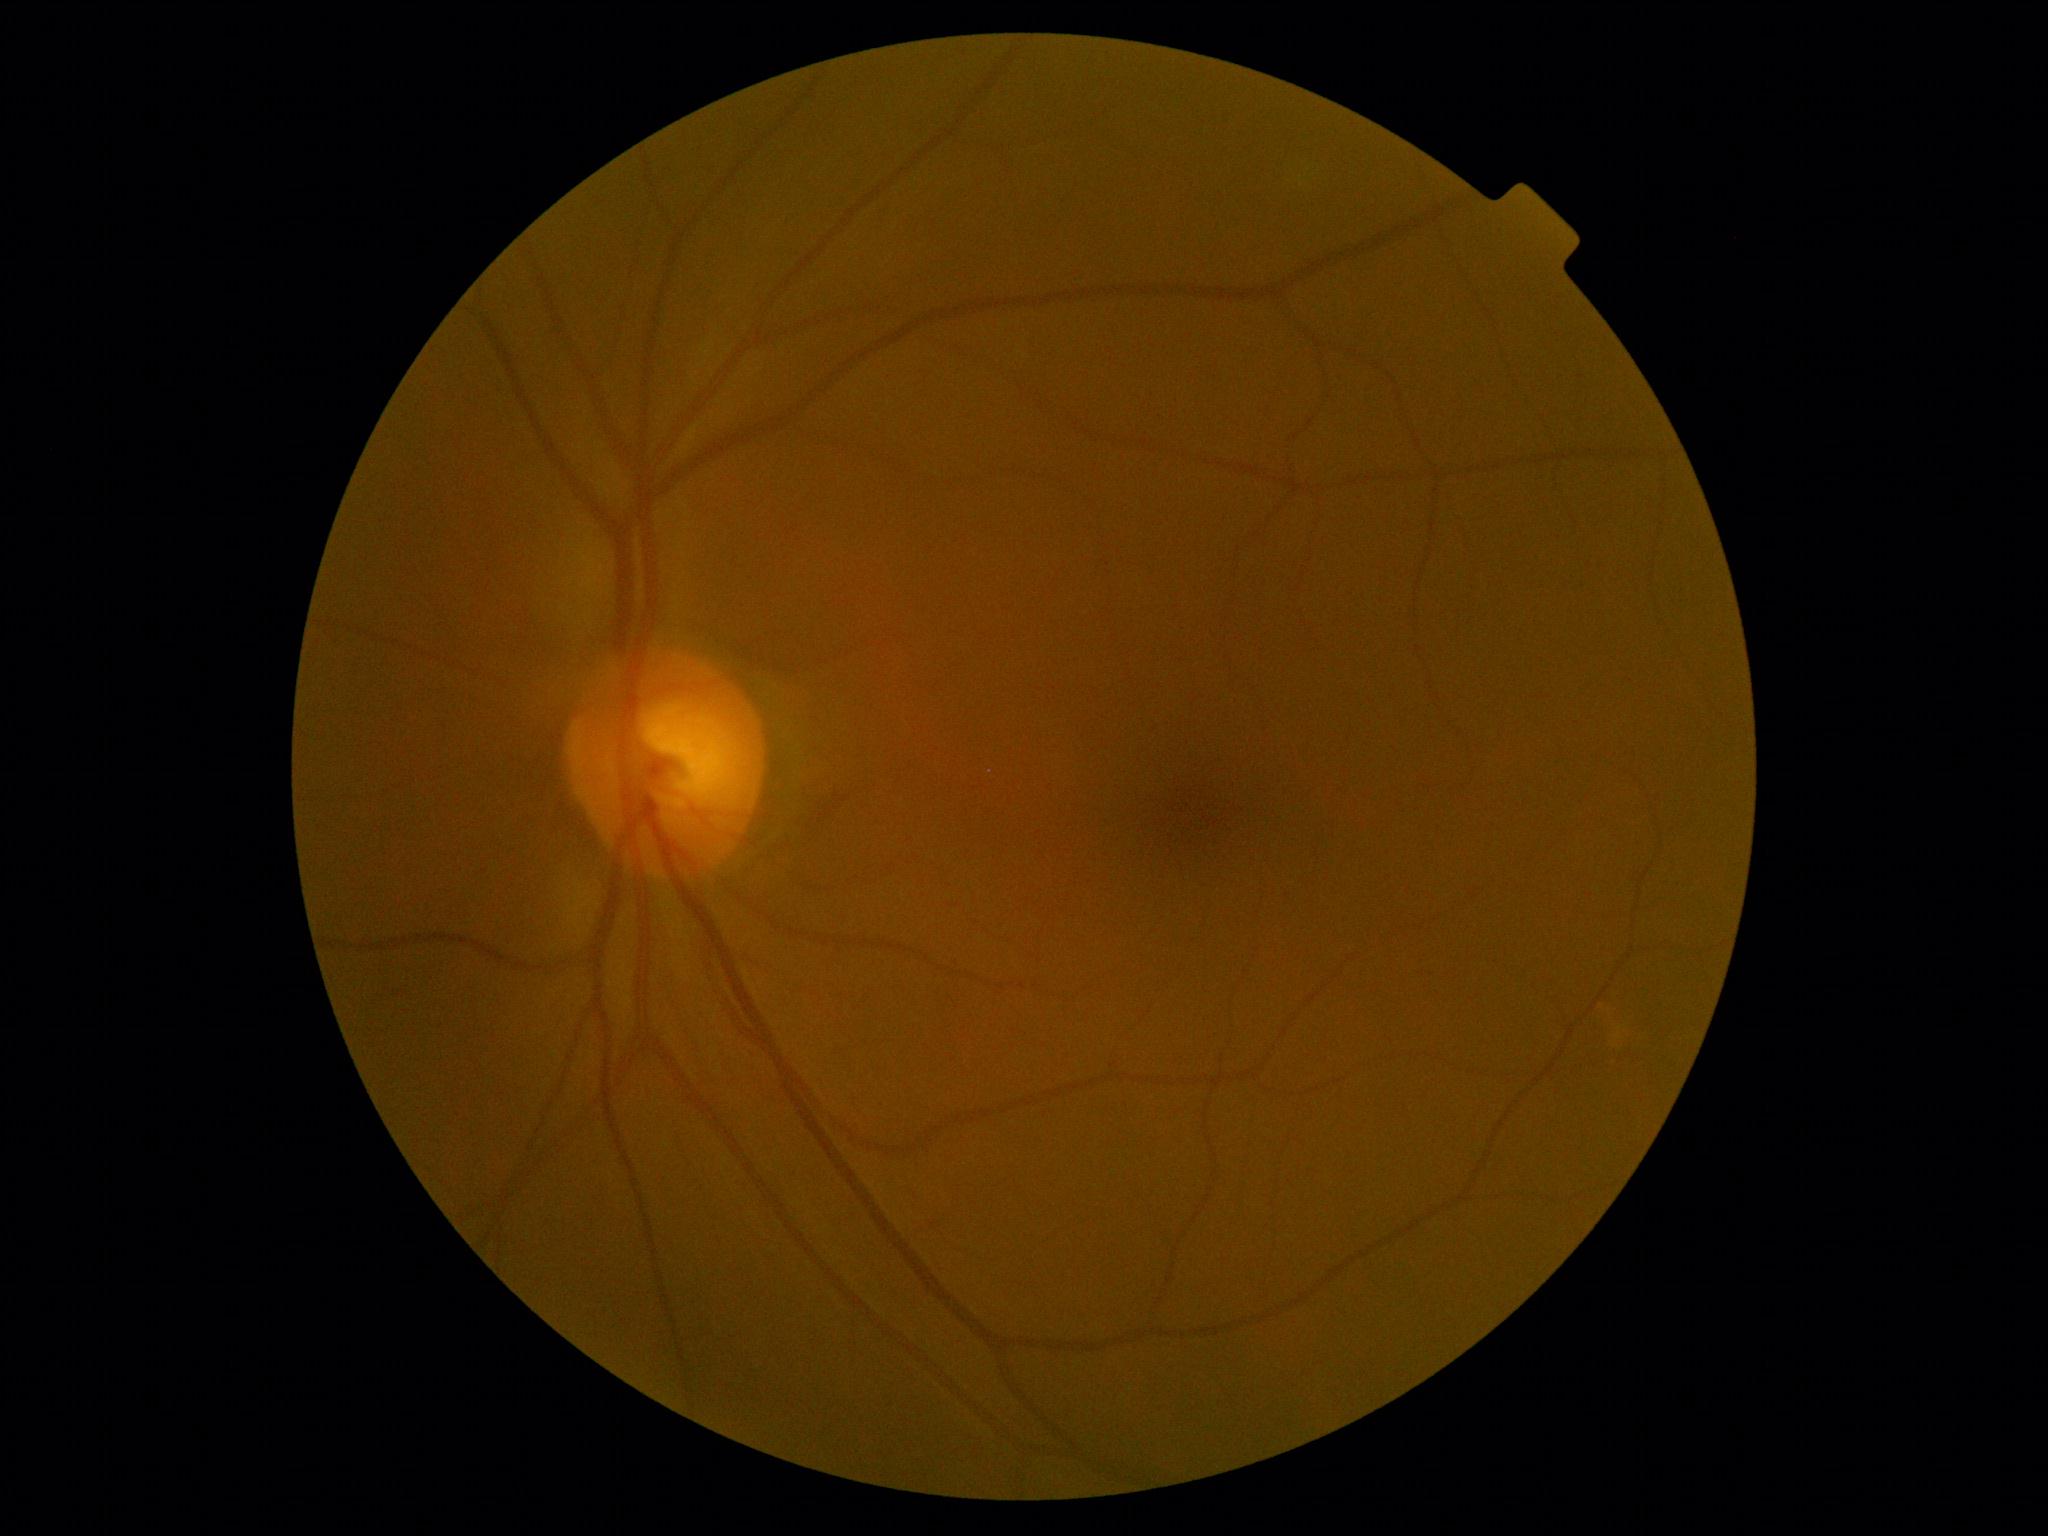
DR stage is 0/4.